NIDEK AFC-230
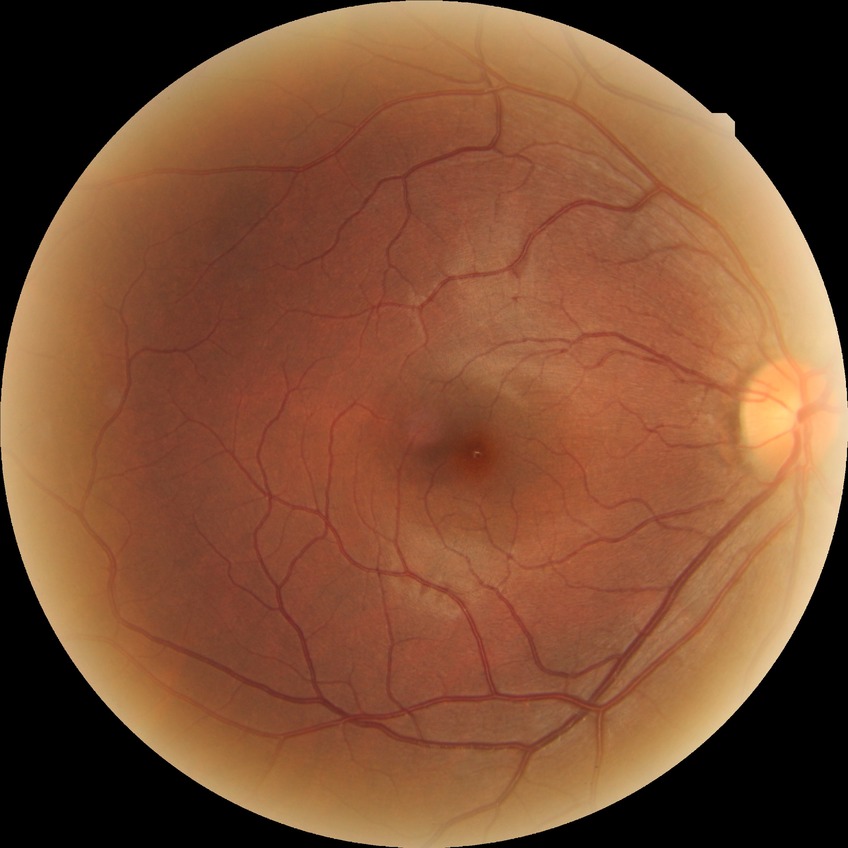 DR: NDR.